2089 by 1764 pixels — 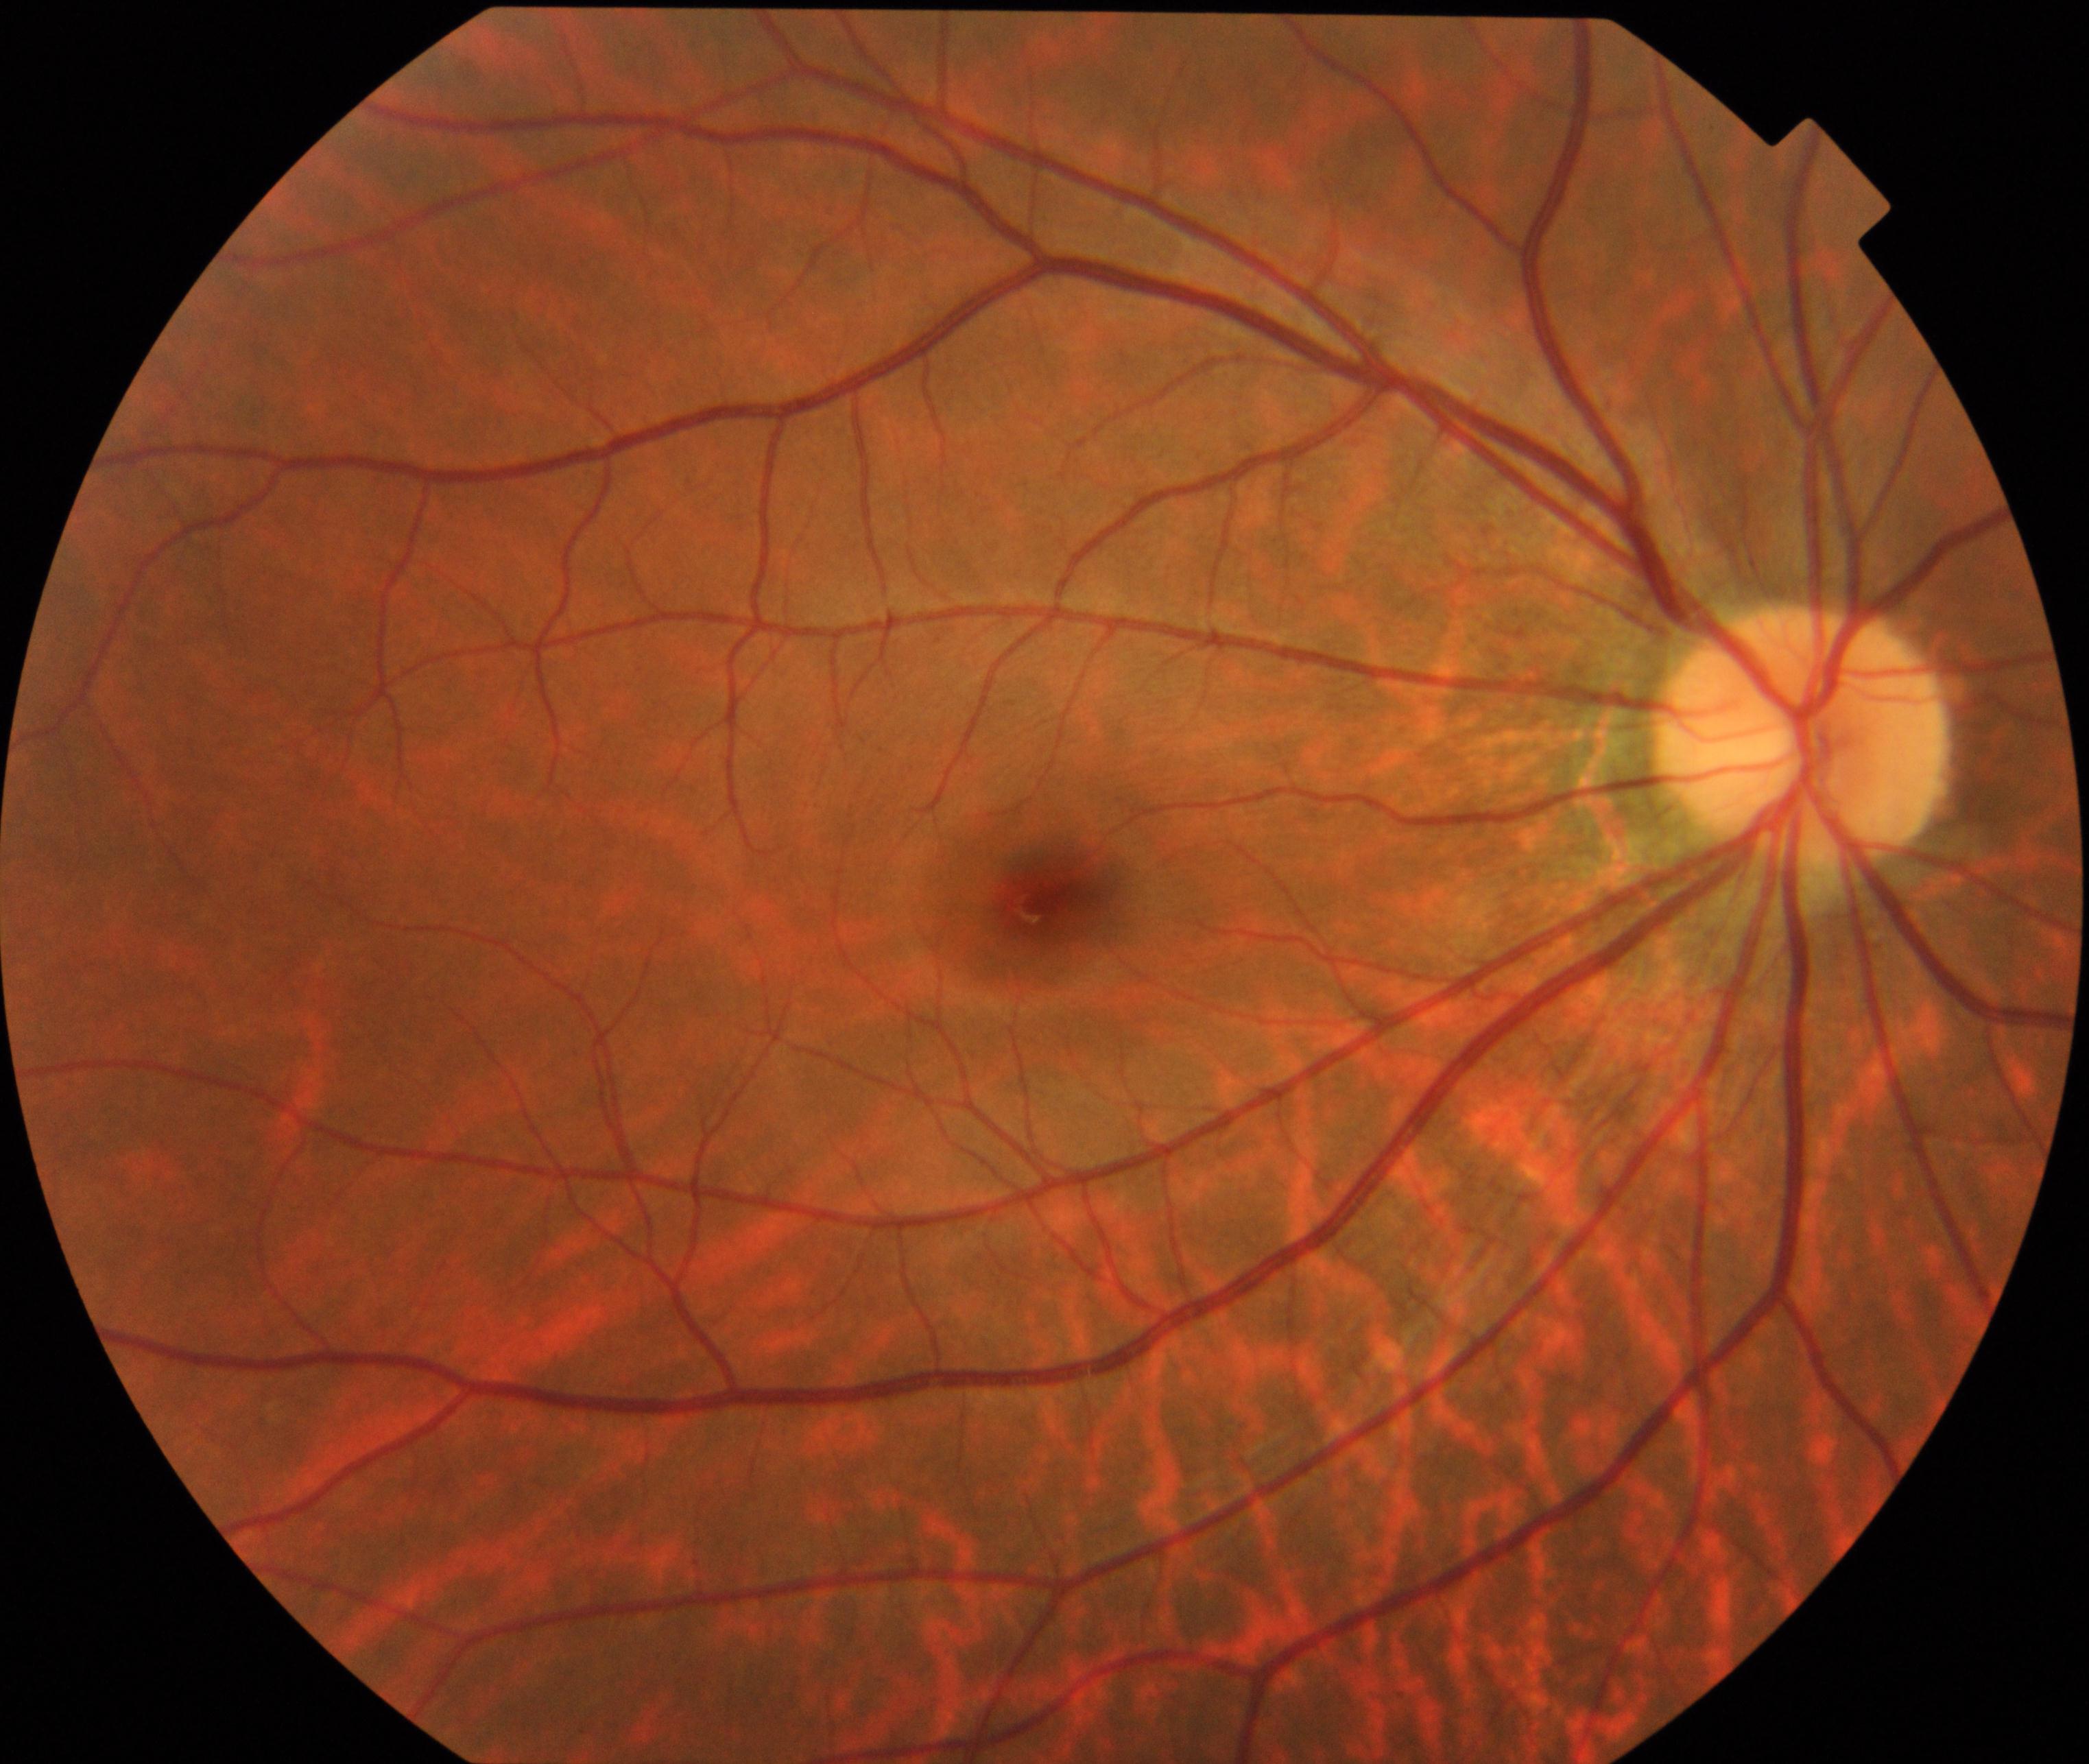 Impression: tessellated fundus.